1932x1910; color fundus image; 45-degree field of view
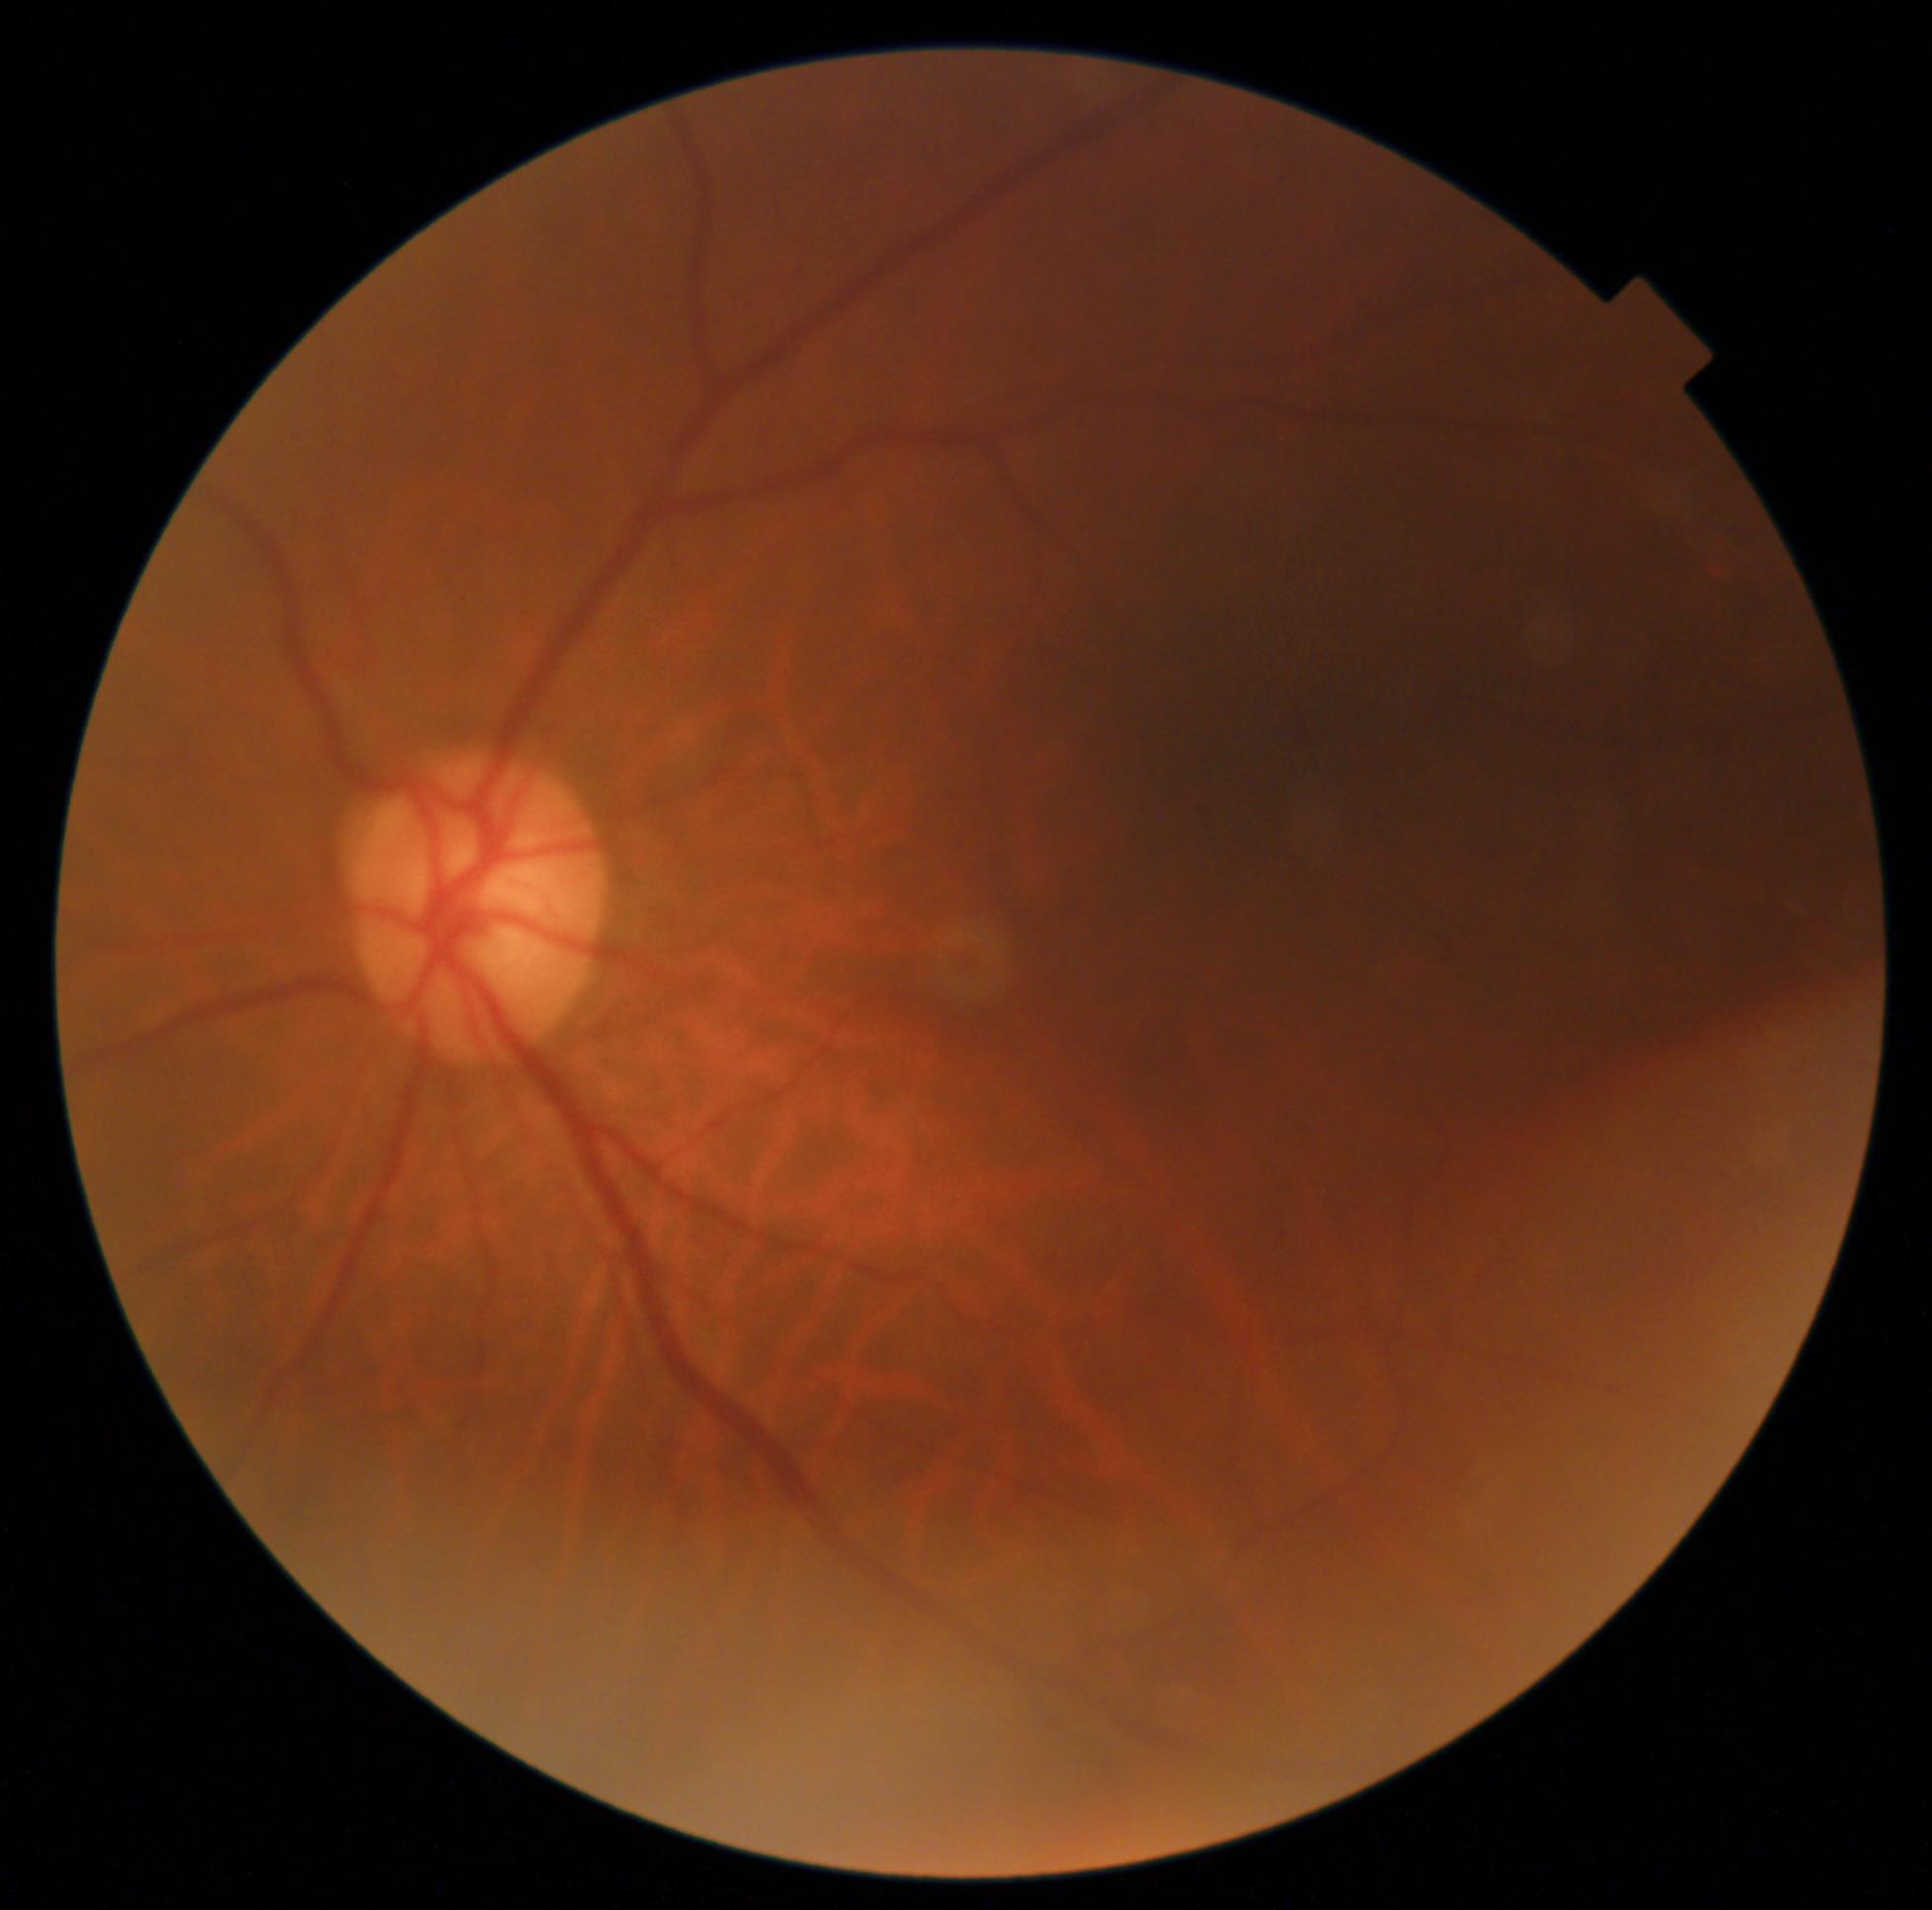

Diabetic retinopathy grade: no apparent retinopathy (0). No signs of diabetic retinopathy.